1659x2212: 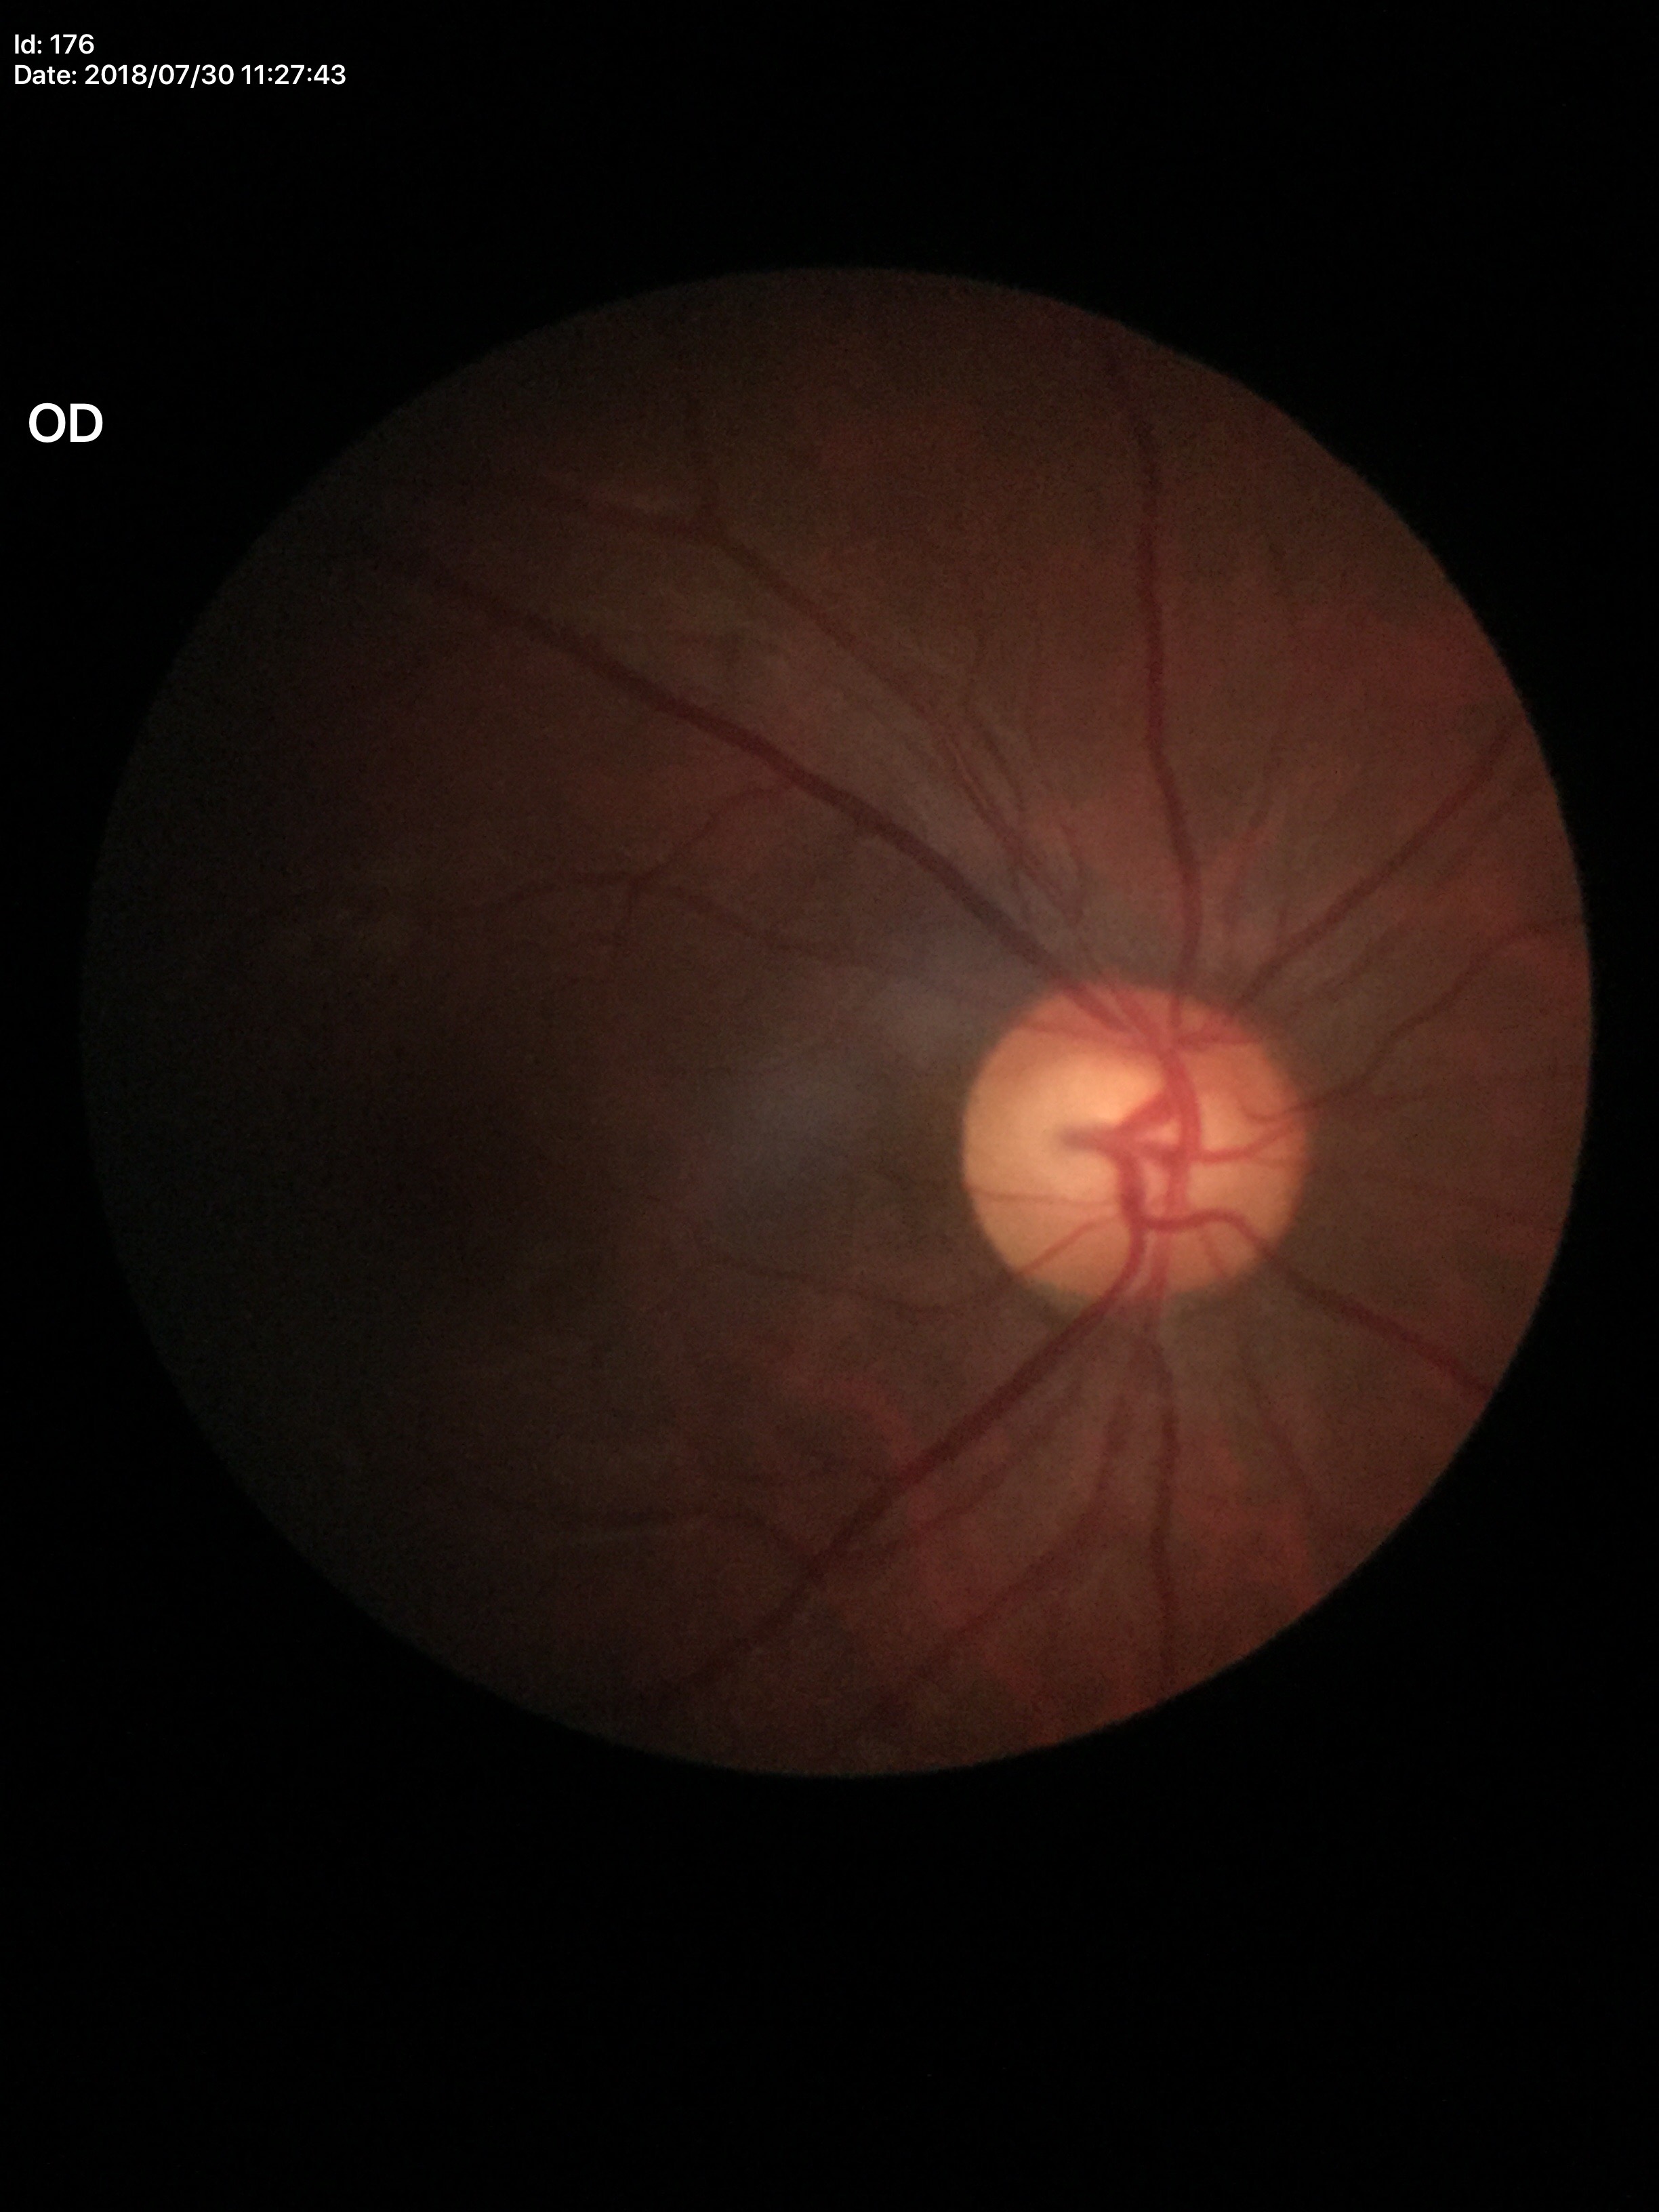 area C/D ratio: 0.38 | vertical C/D ratio: 0.60 | Glaucoma screening: no suspicious findings